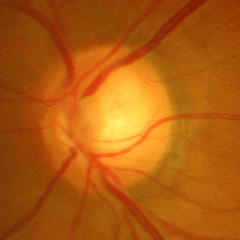

Fundus image with findings of advanced glaucomatous optic neuropathy.